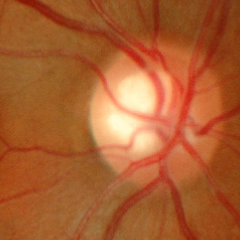 No glaucomatous optic neuropathy.